Infant wide-field retinal image; Phoenix ICON, 100° FOV; 1240 by 1240 pixels:
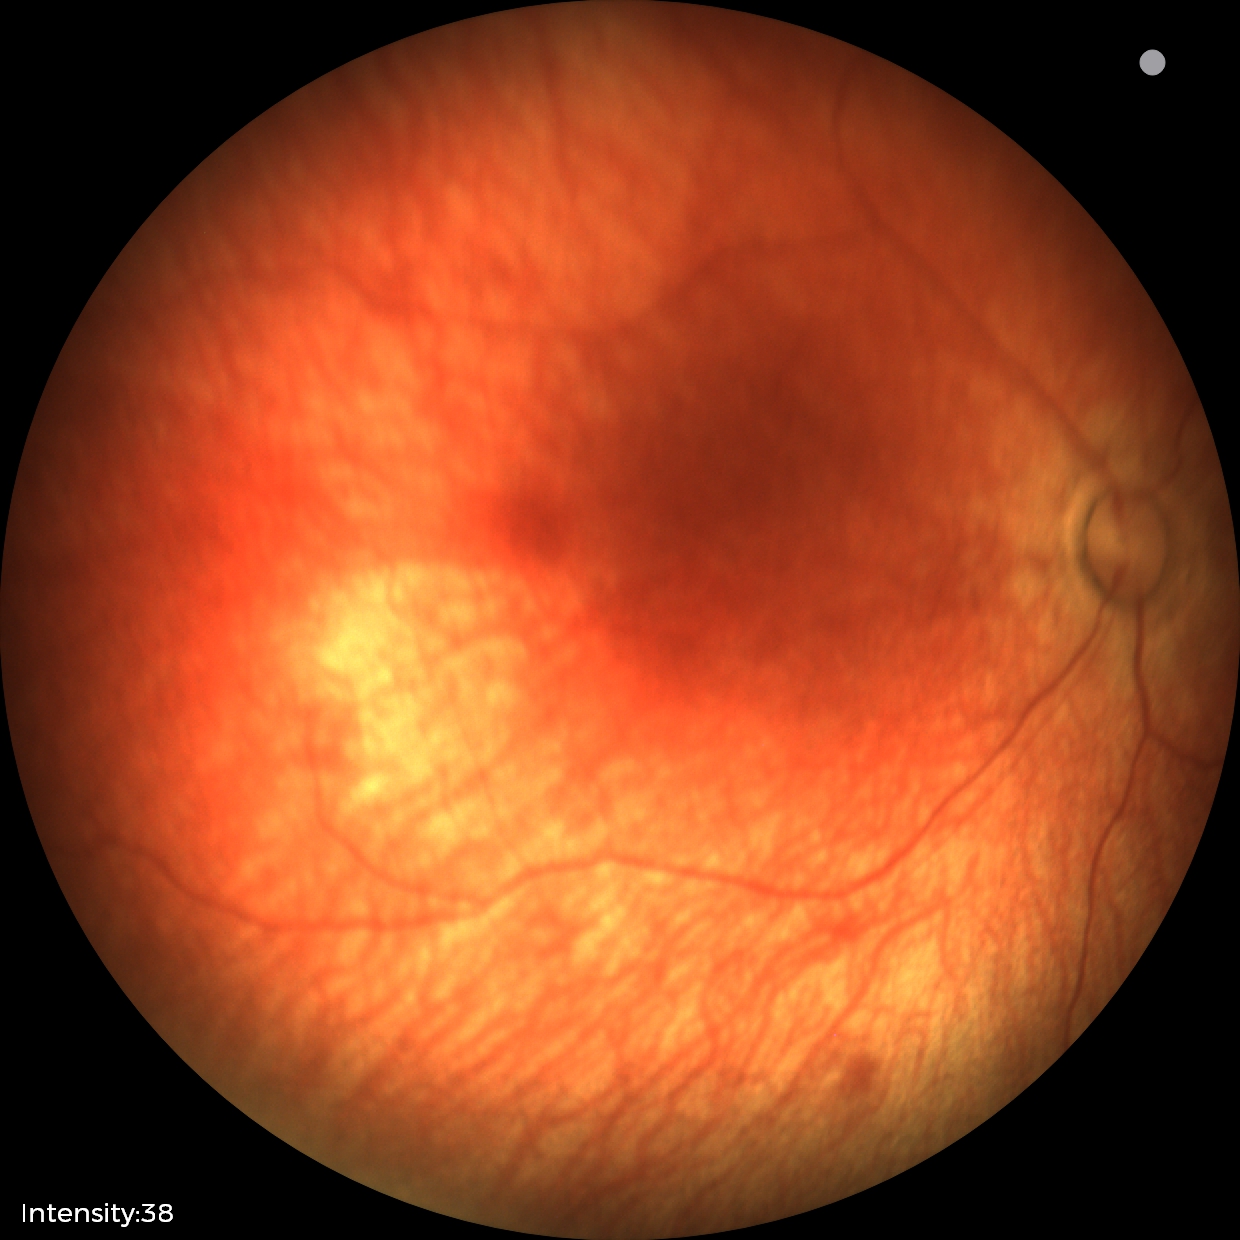
No retinal pathology identified on screening.